45° FOV; 2048 x 1536 pixels.
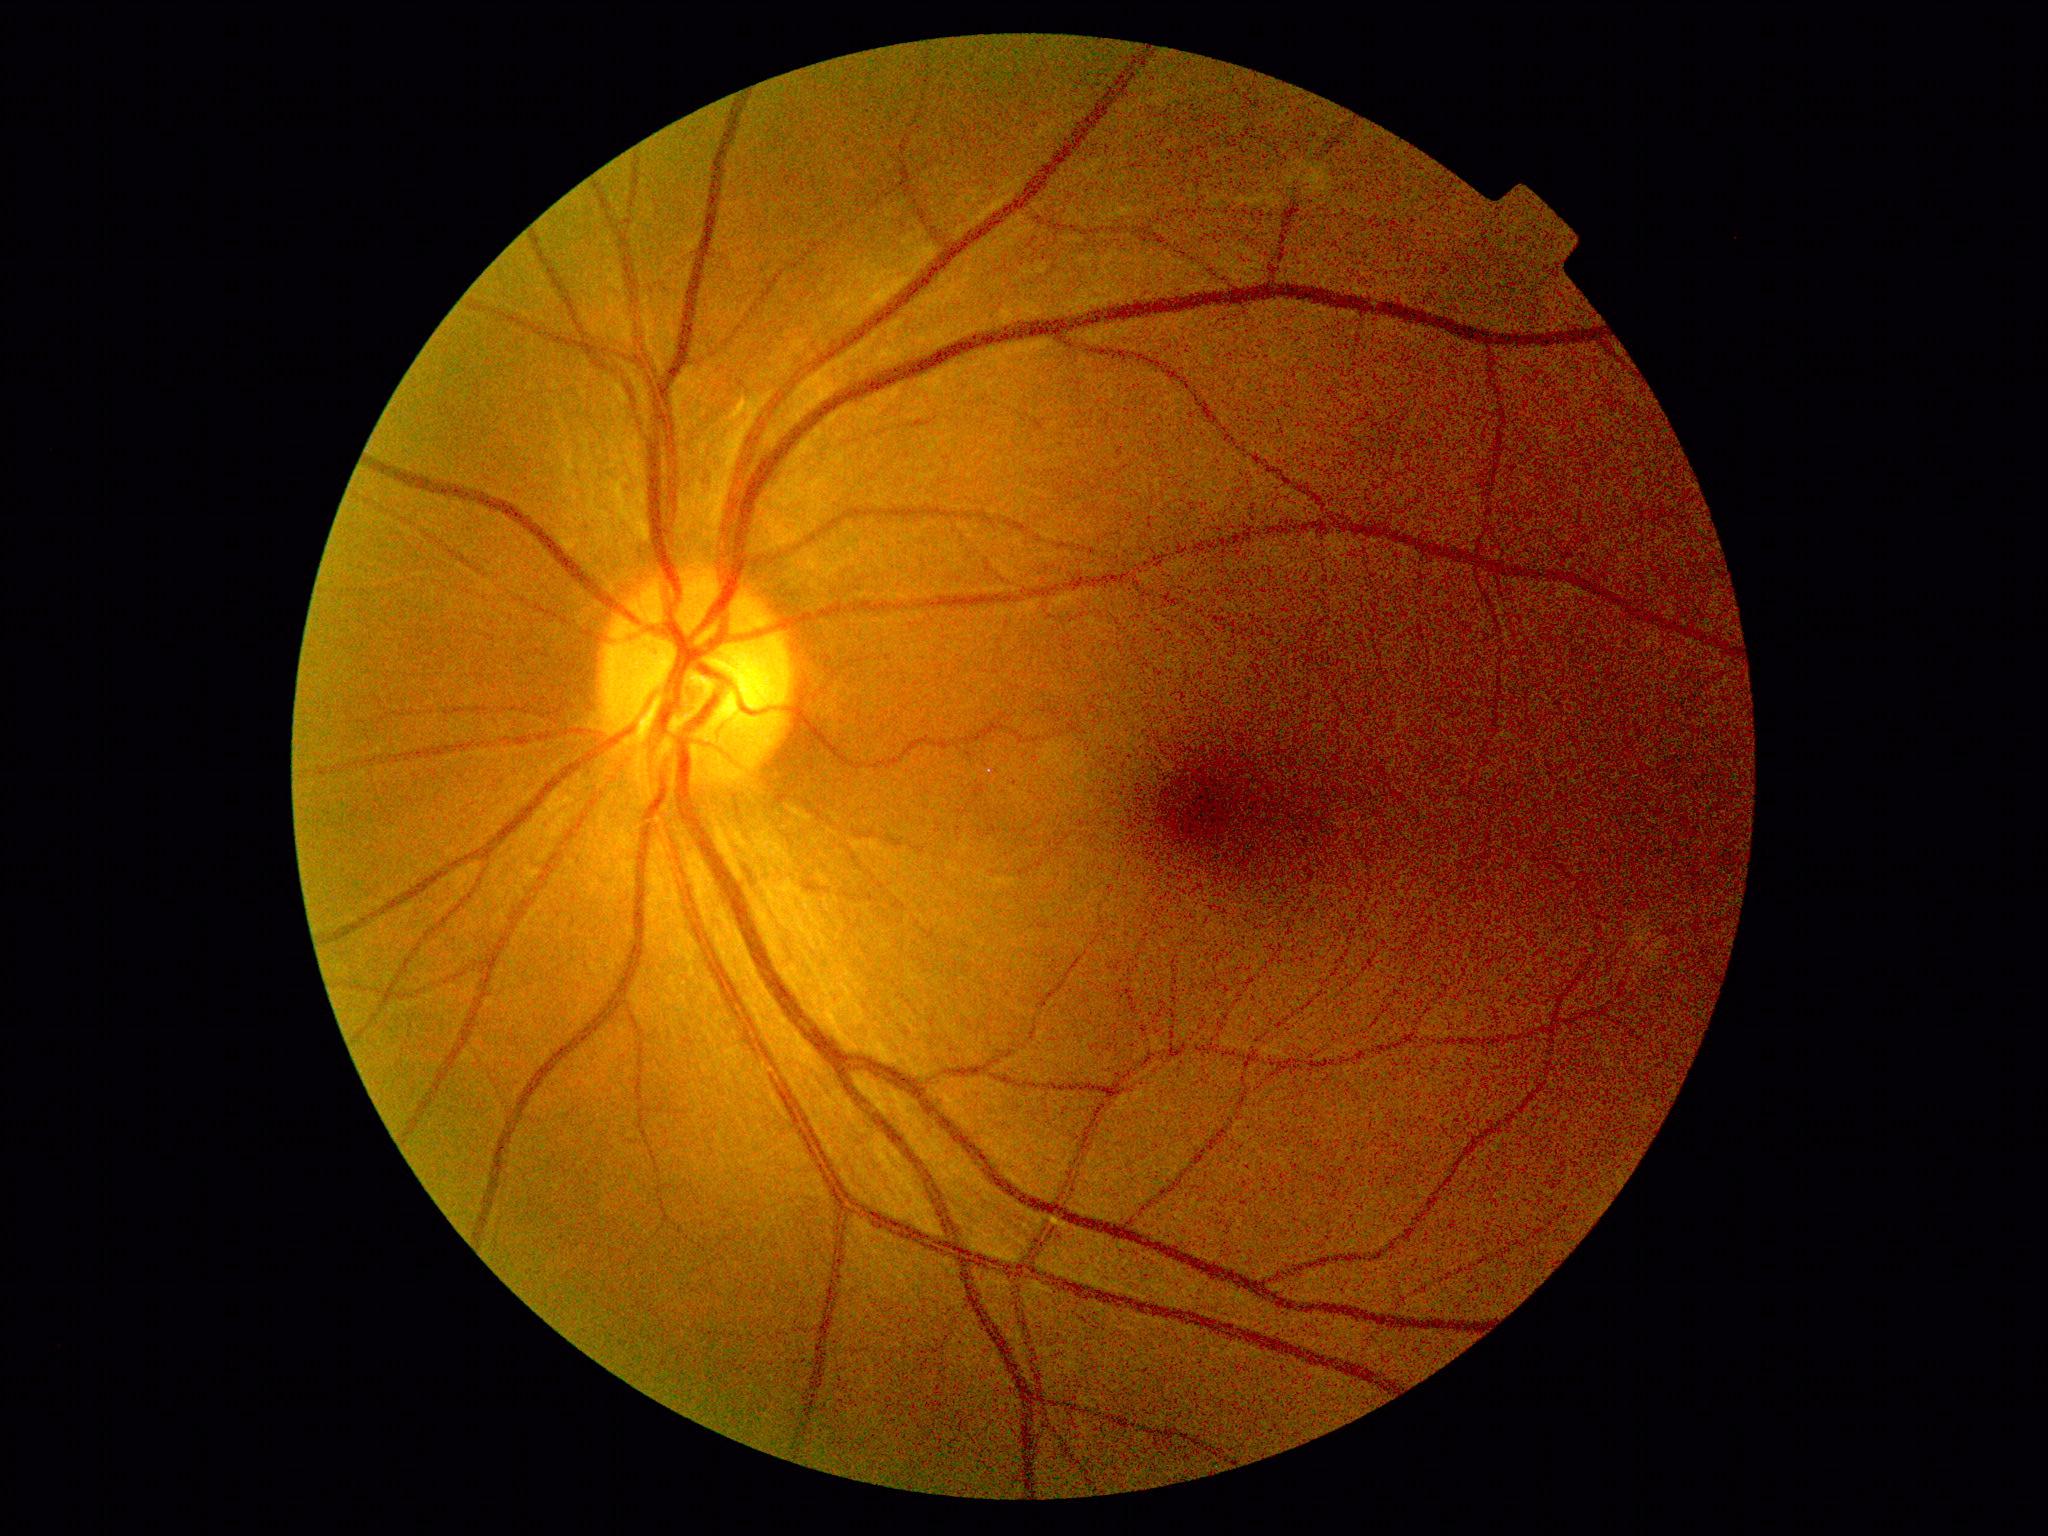
DR impression=no apparent DR; diabetic retinopathy (DR)=grade 0 (no apparent retinopathy).